45-degree field of view; retinal fundus photograph:
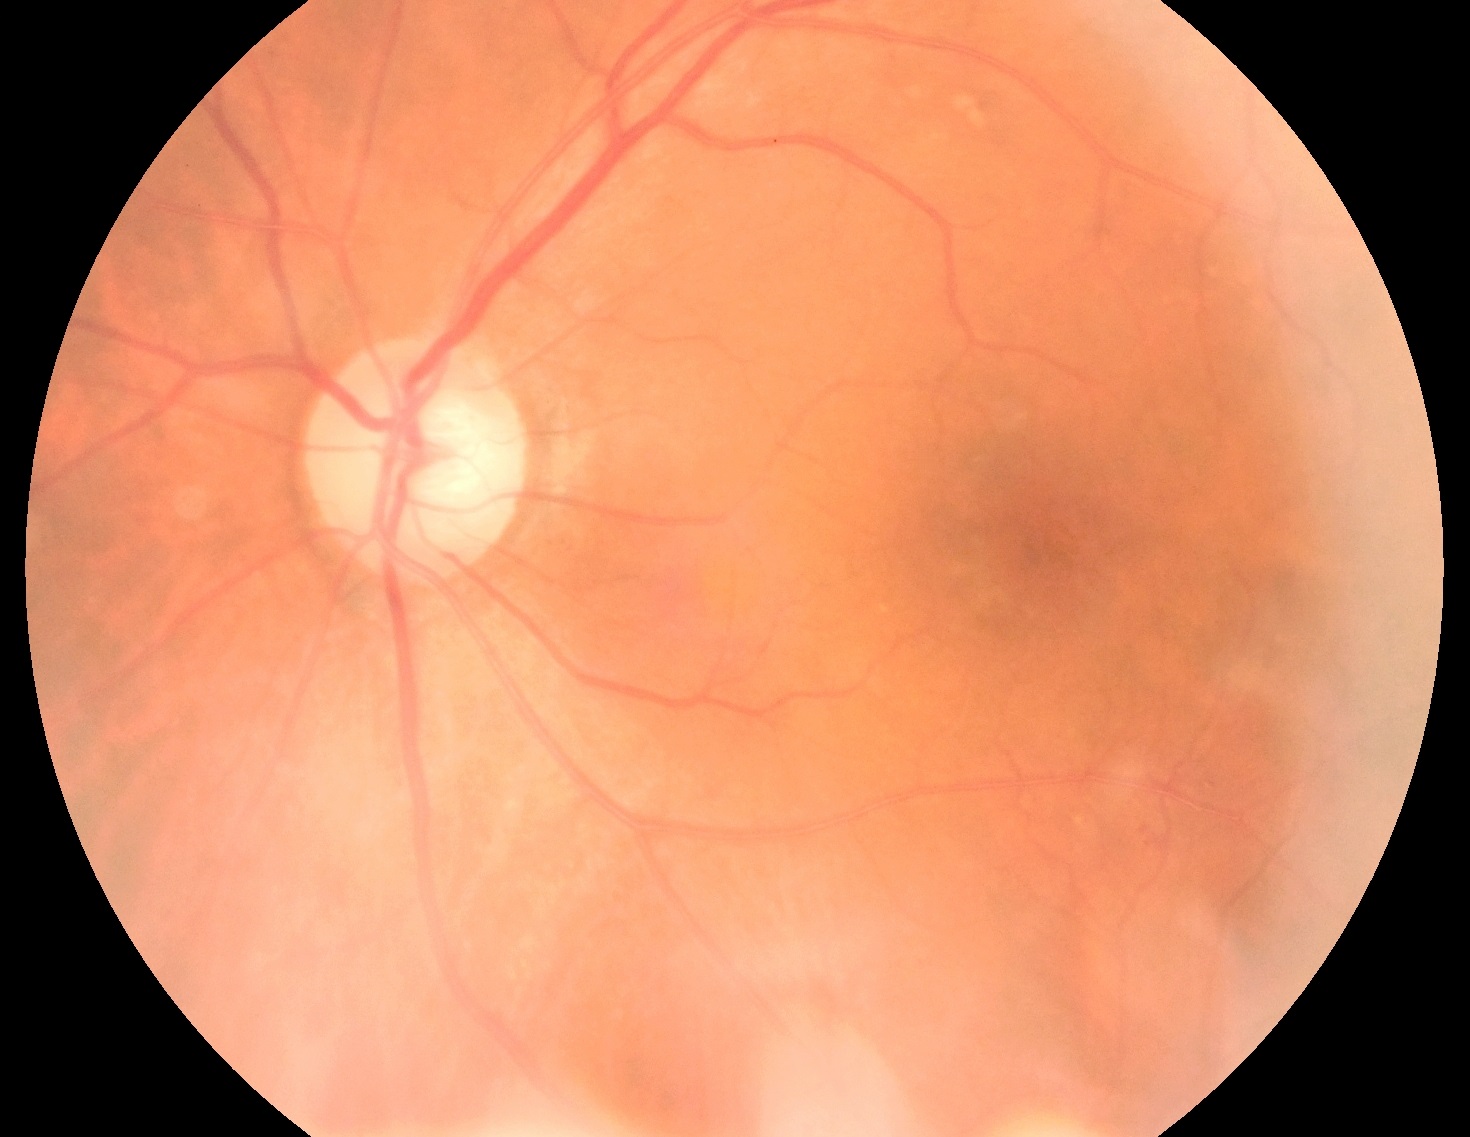 Diabetic retinopathy severity is 2/4.